240 x 240 pixels — 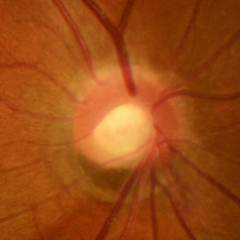
Diagnosis: early-stage glaucoma.